2089x1764; color fundus photograph
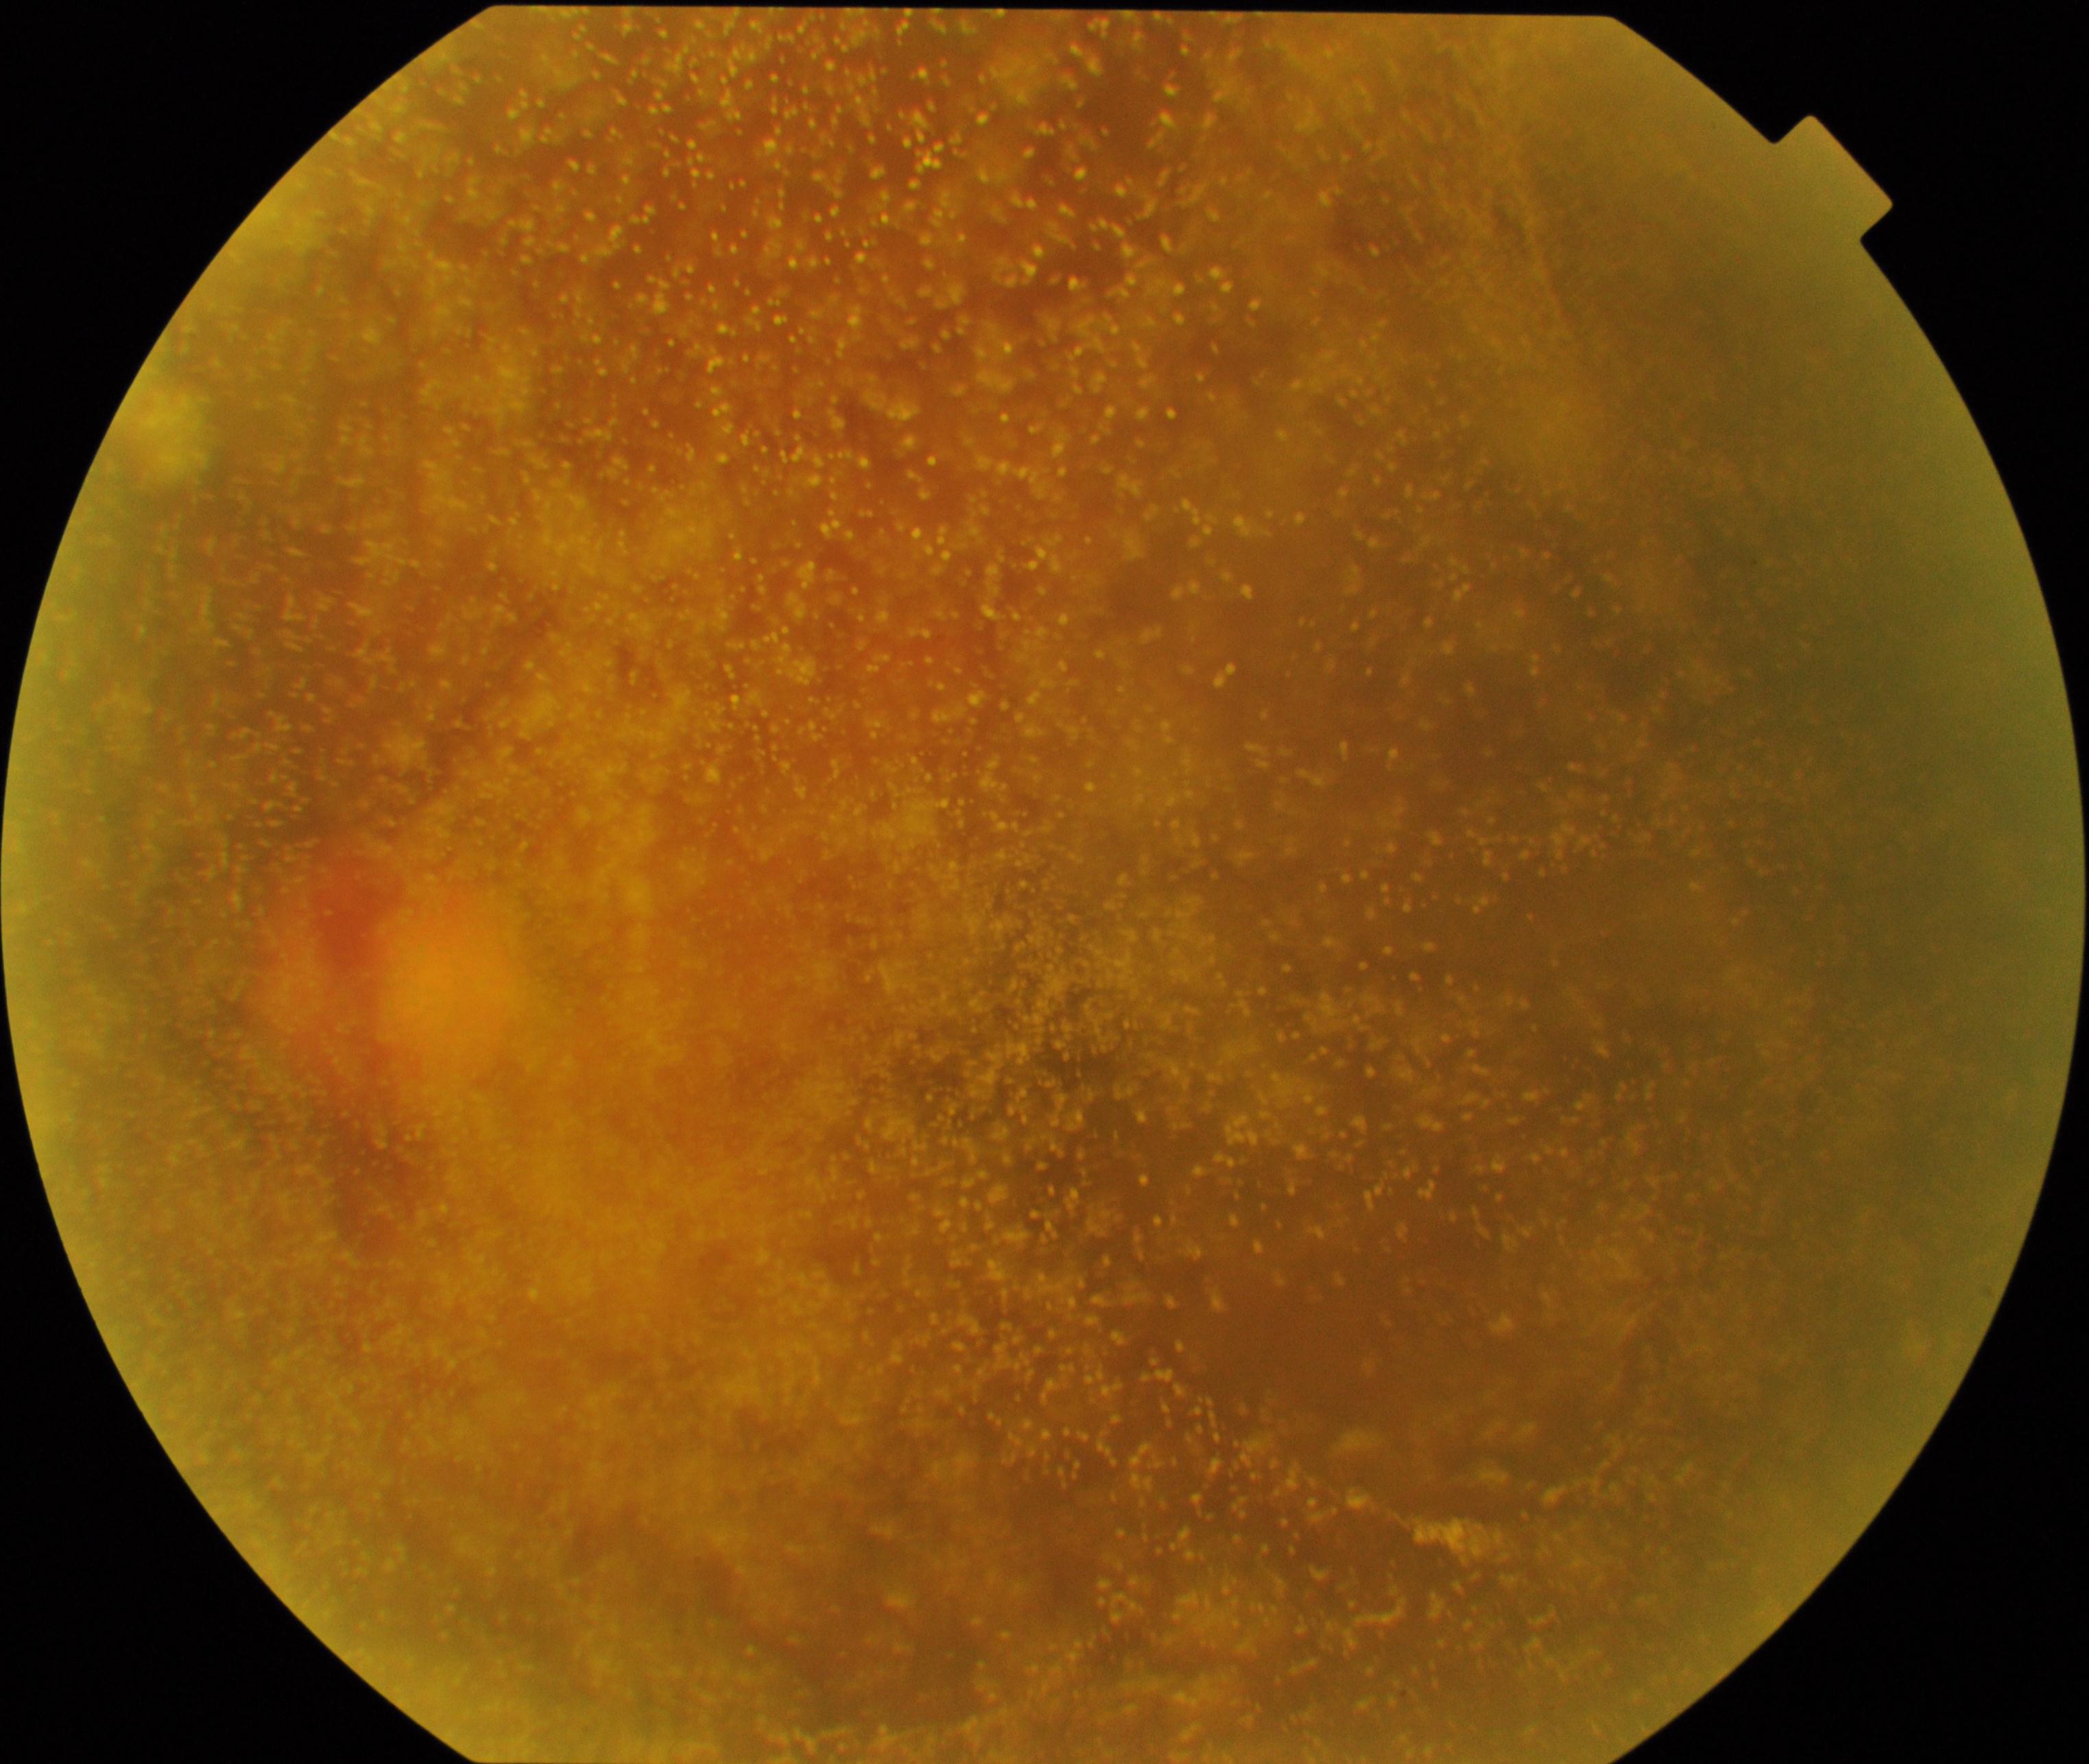

There is evidence of vitreous particles.